2352x1568; 45° field of view:
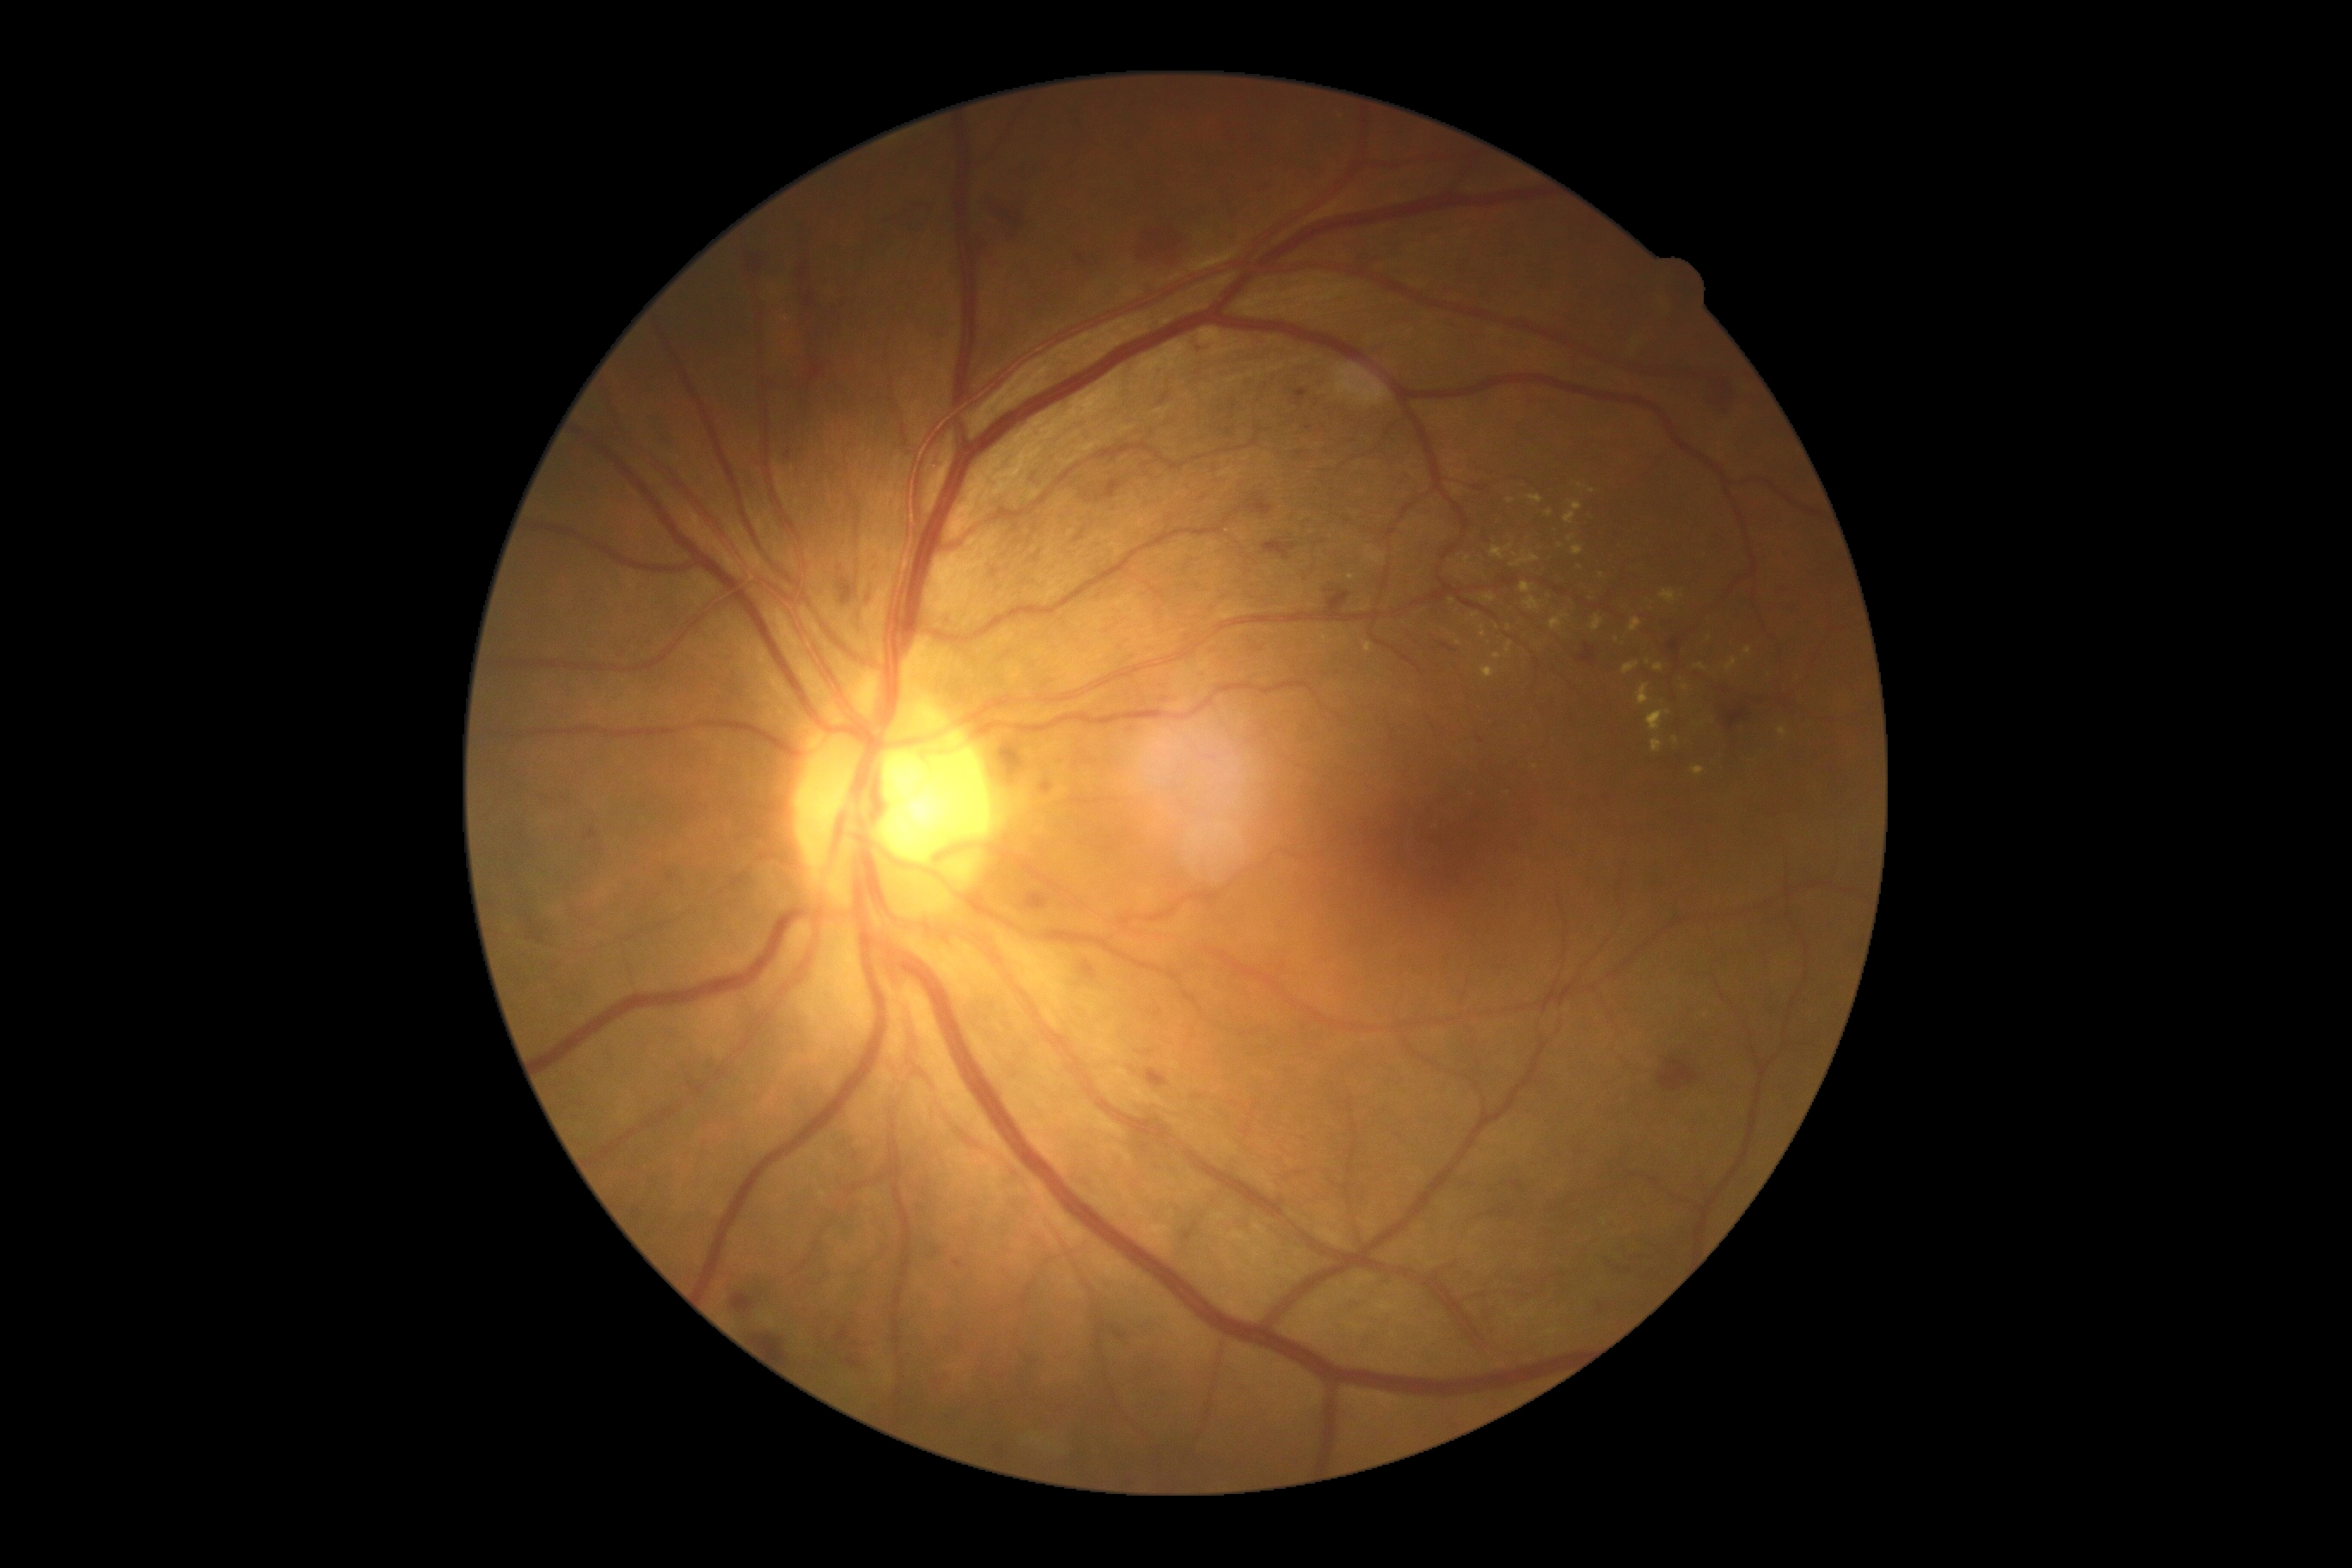 DR stage = grade 2 (moderate NPDR).